Infant wide-field fundus photograph — 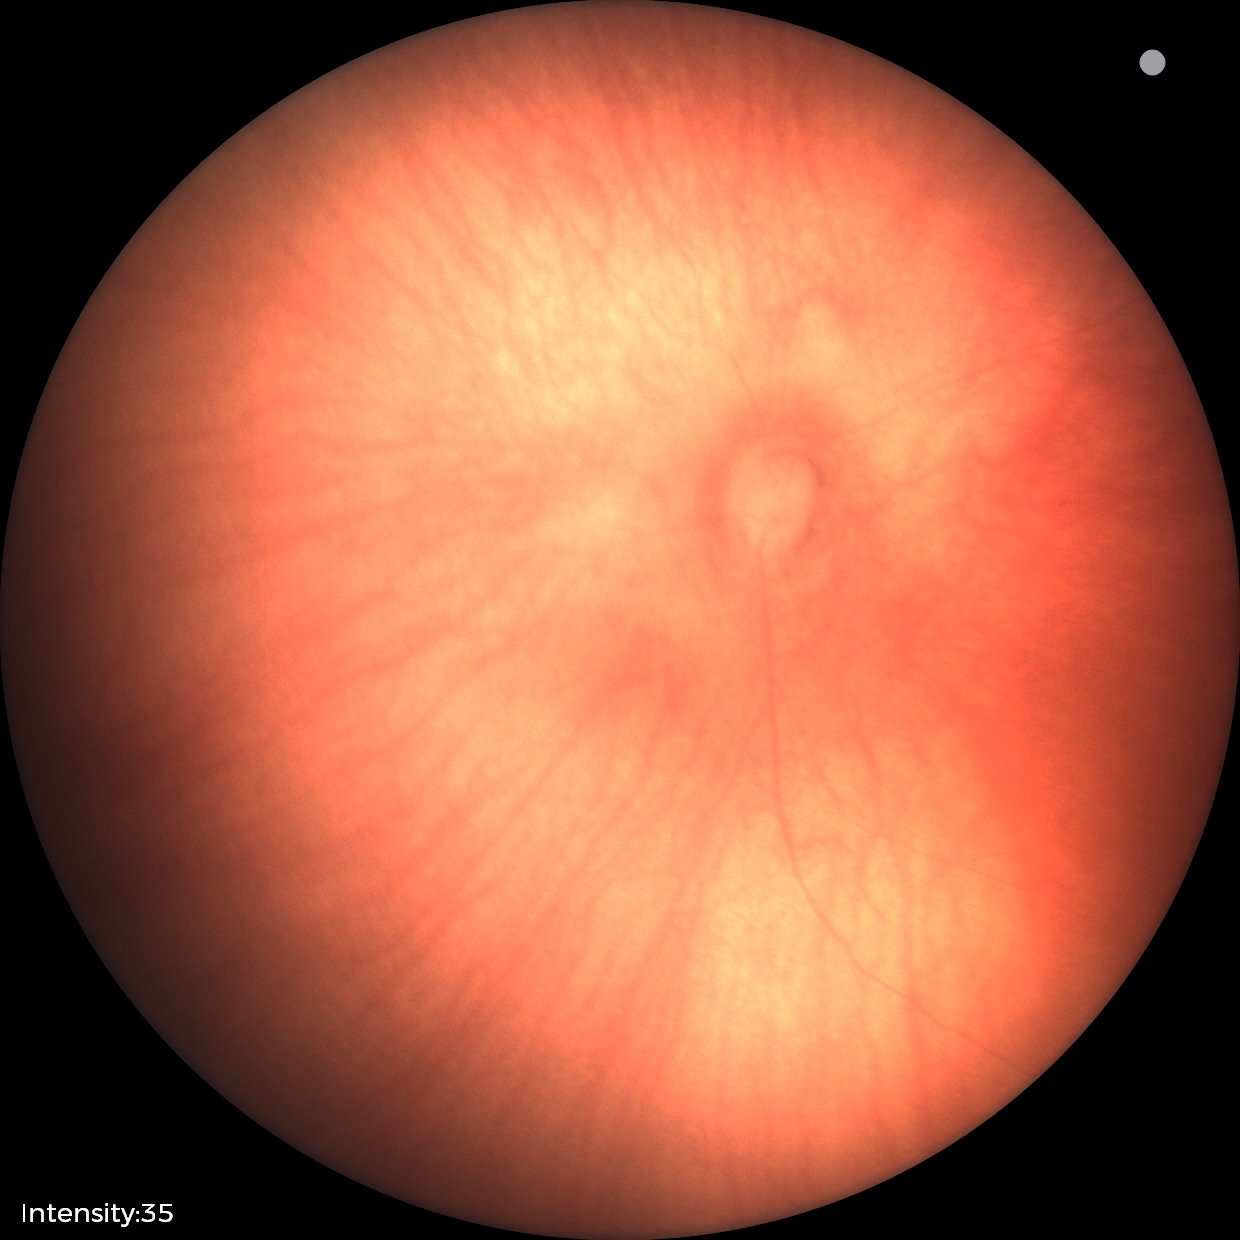
Normal screening examination.